CFP.
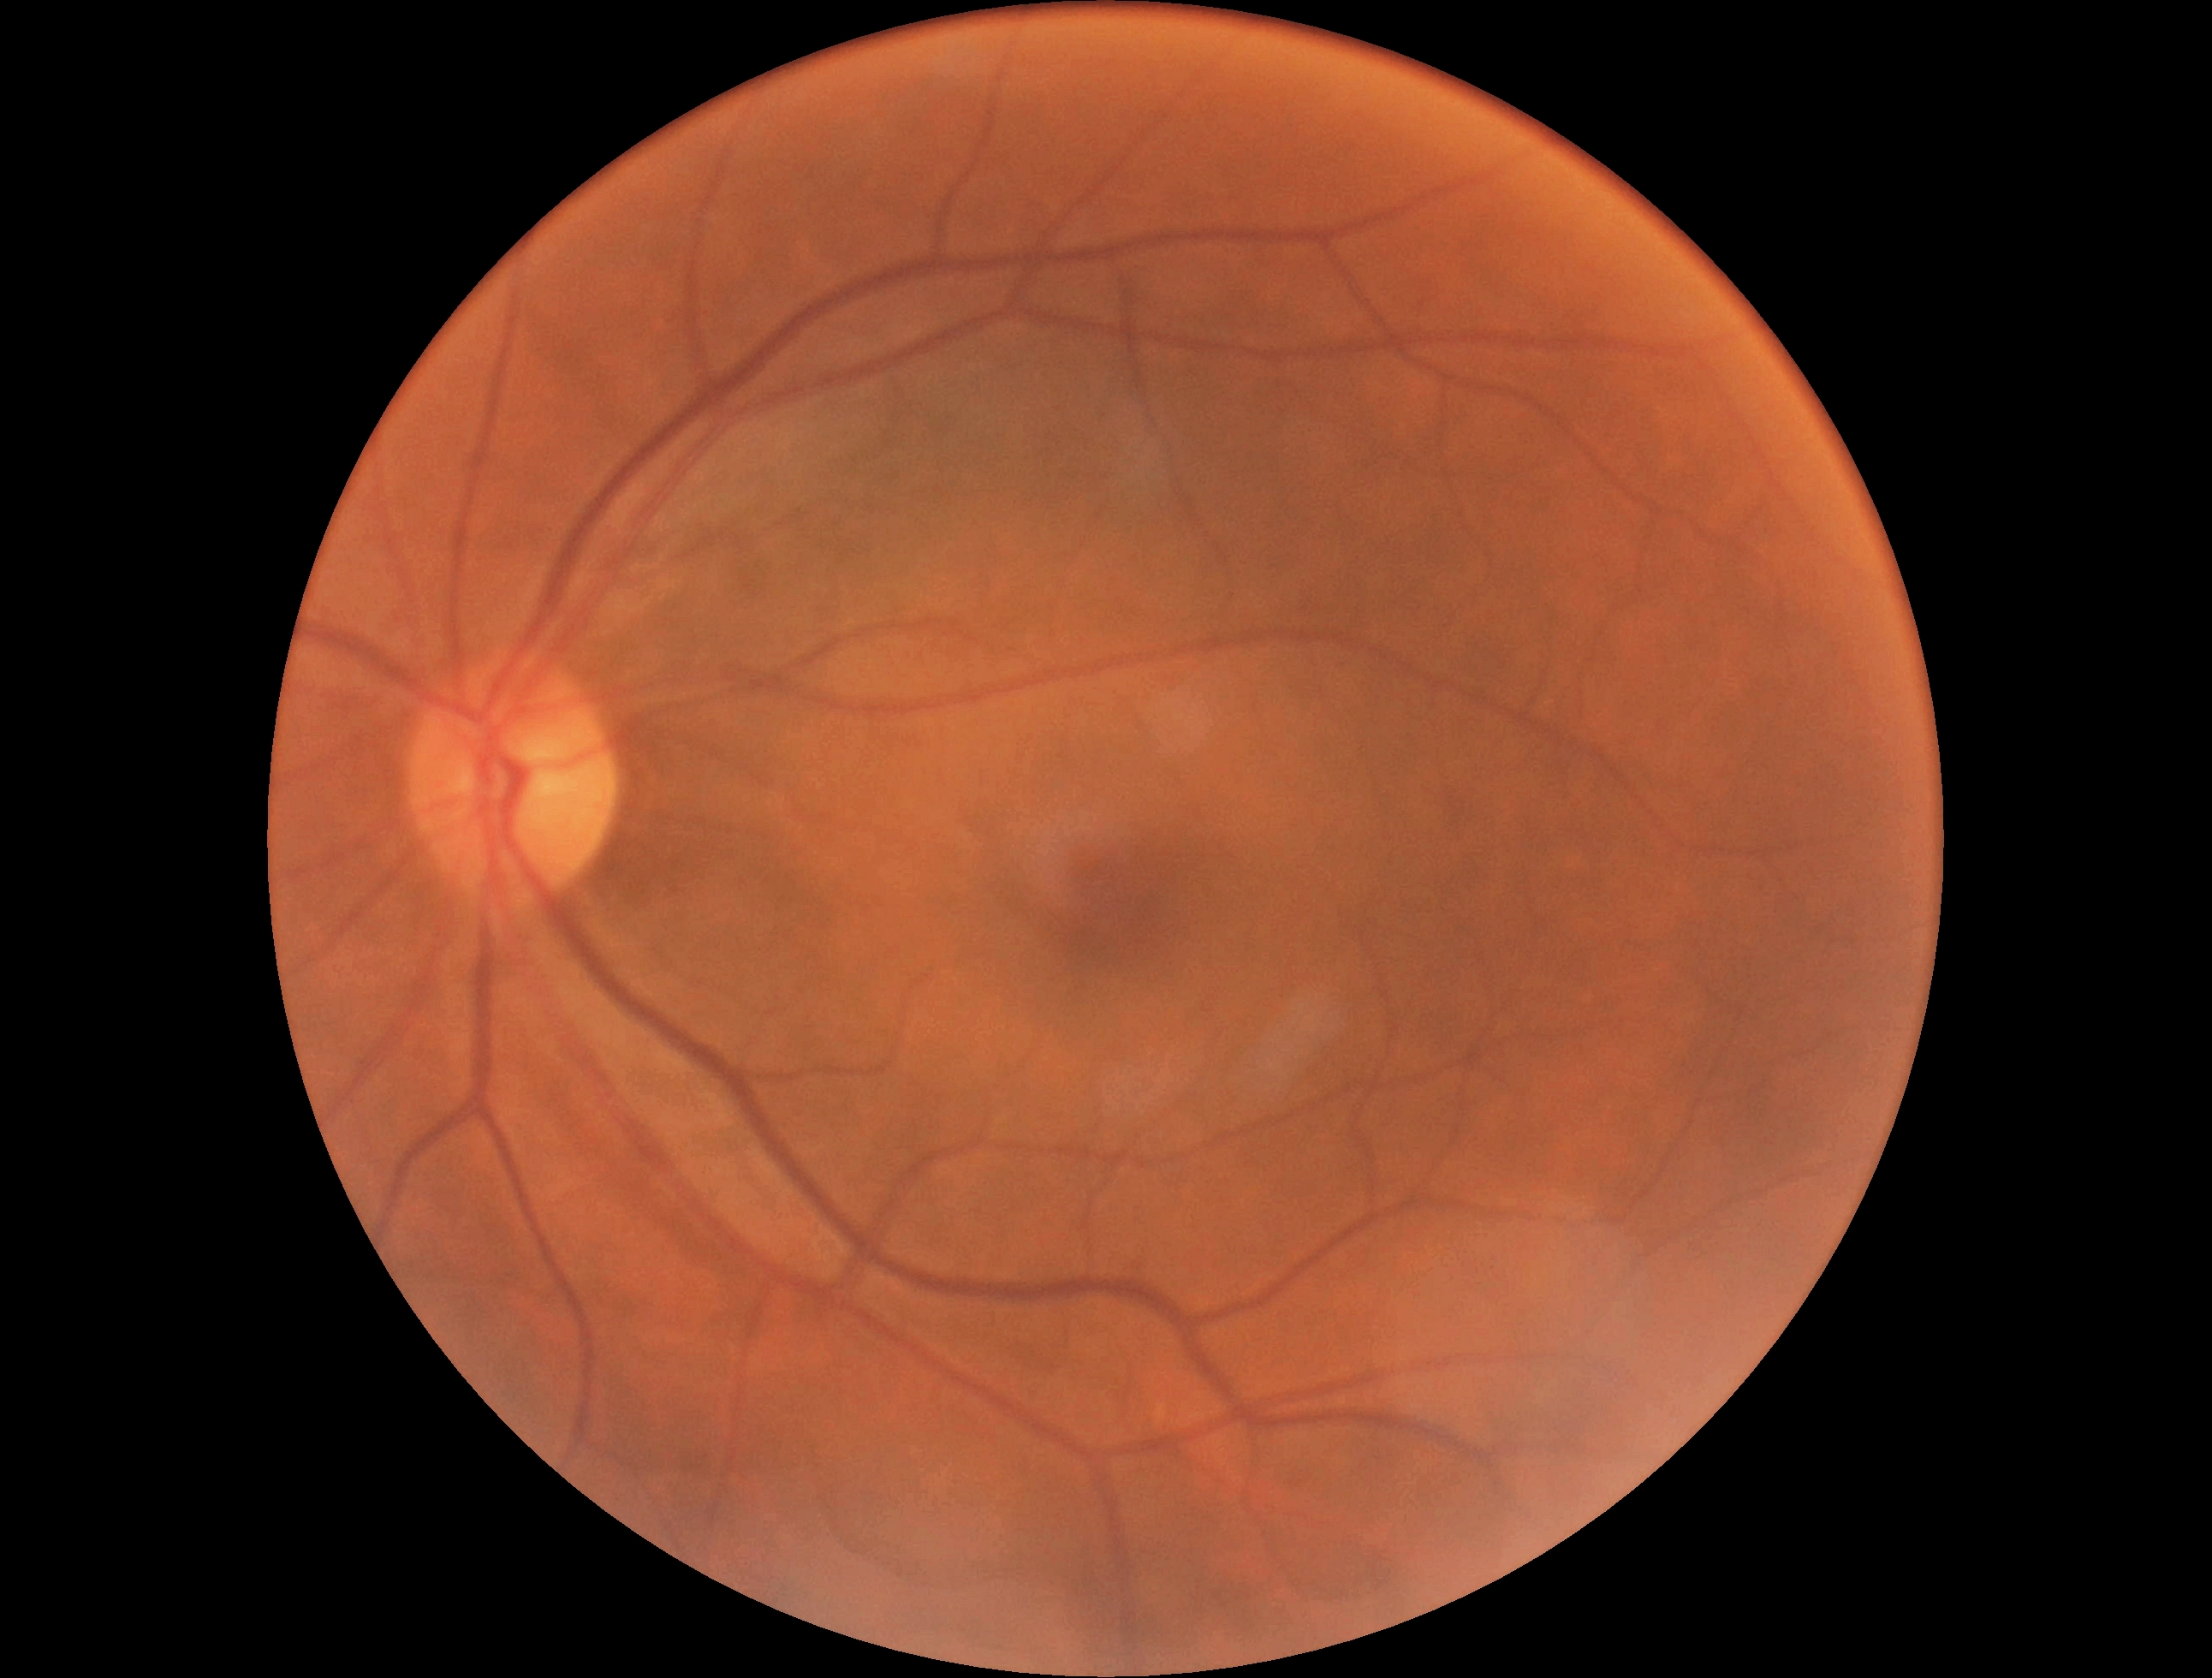
Diabetic retinopathy: grade 0 (no apparent retinopathy).